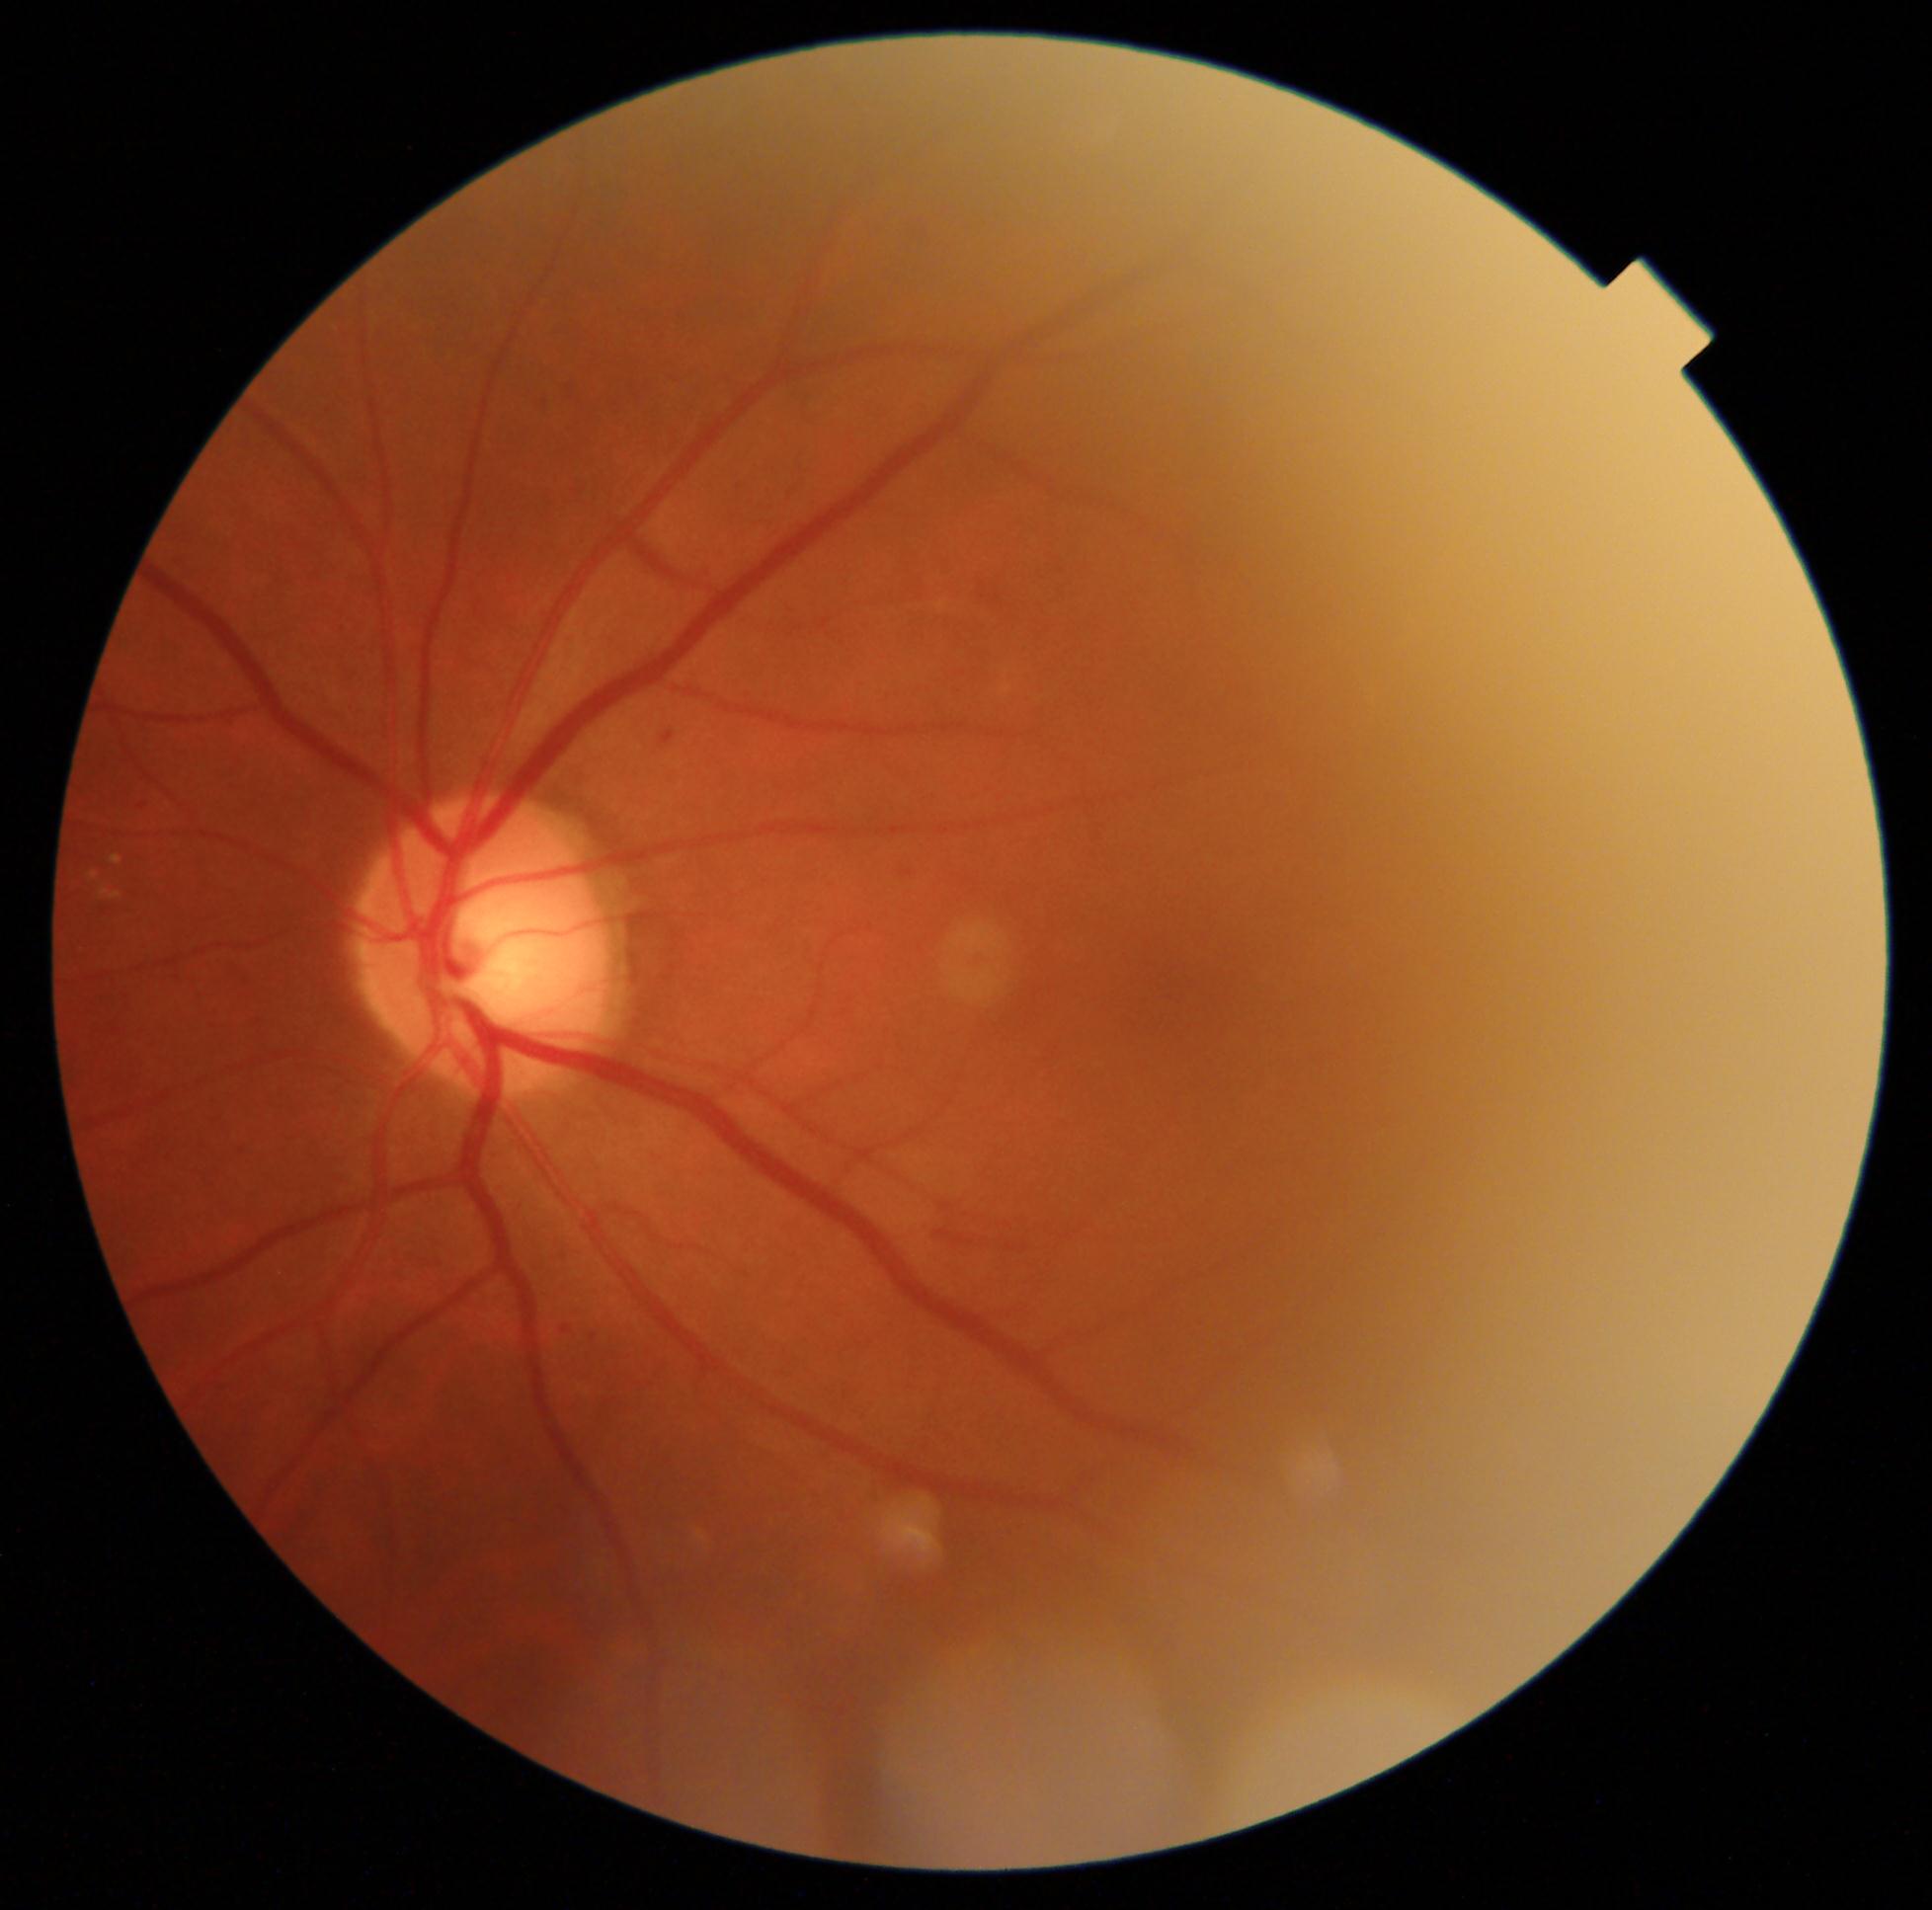
  dr_grade: moderate non-proliferative diabetic retinopathy (grade 2)